Topcon TRC-NW8 · fundus photo · 50° field of view: 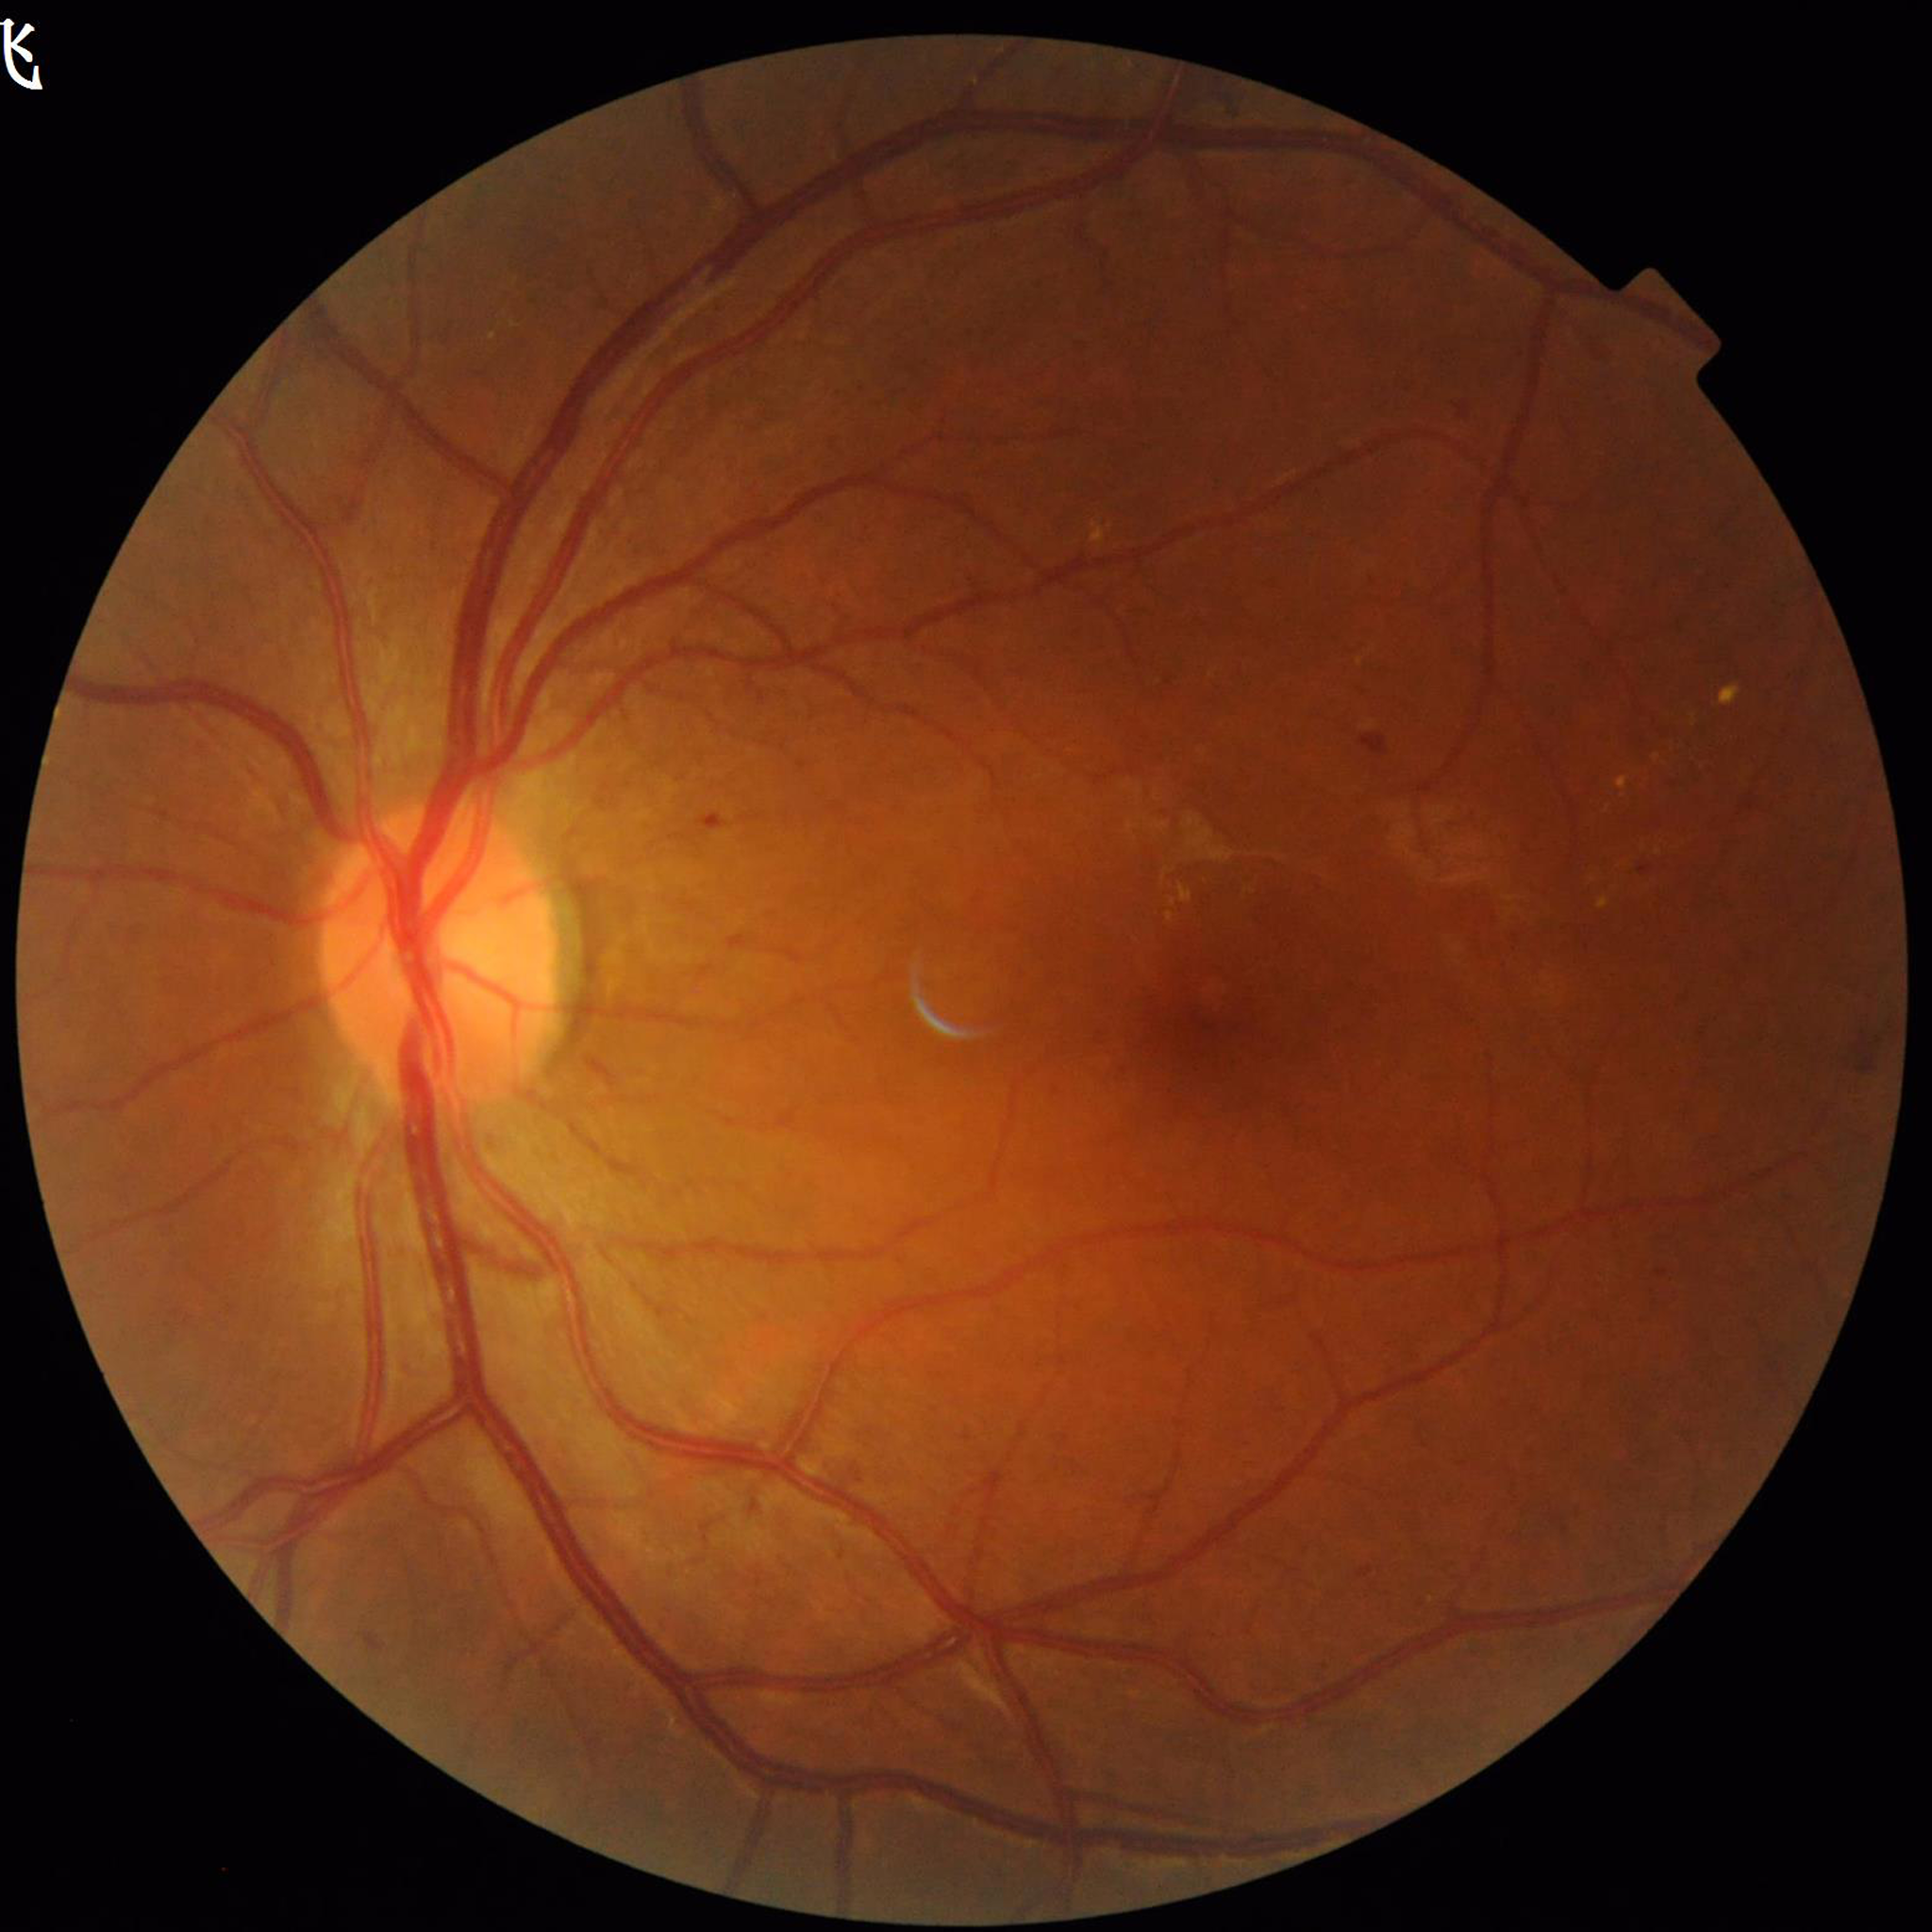
image_quality: good
diagnosis: diabetic retinopathy (DR)